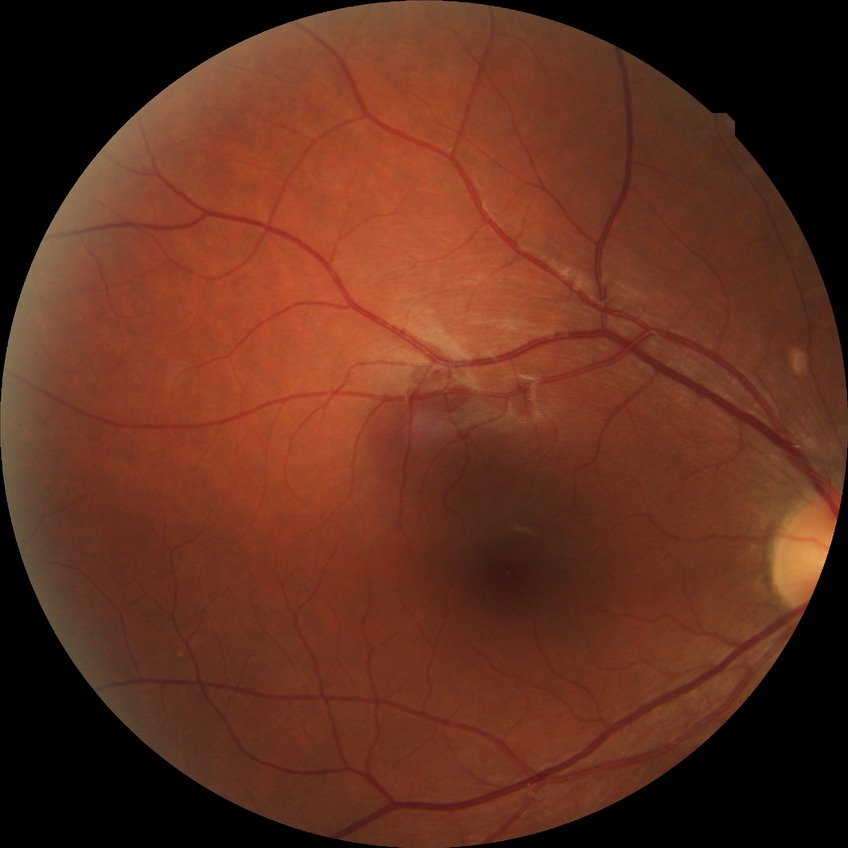 Diabetic retinopathy (DR) is no diabetic retinopathy (NDR).